Pediatric retinal photograph (wide-field) — 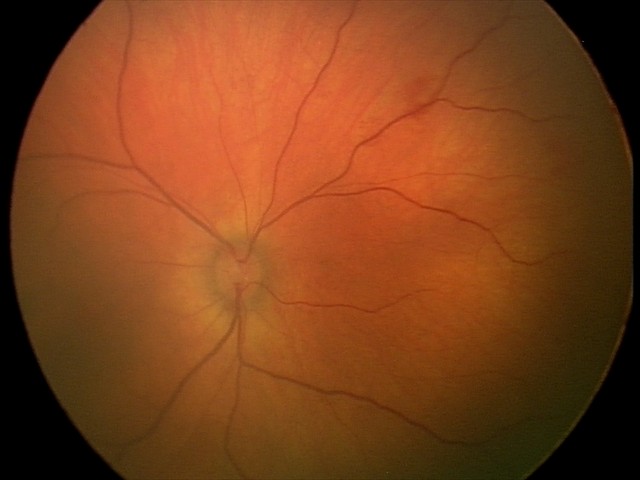 Series diagnosed as retinal hemorrhages.